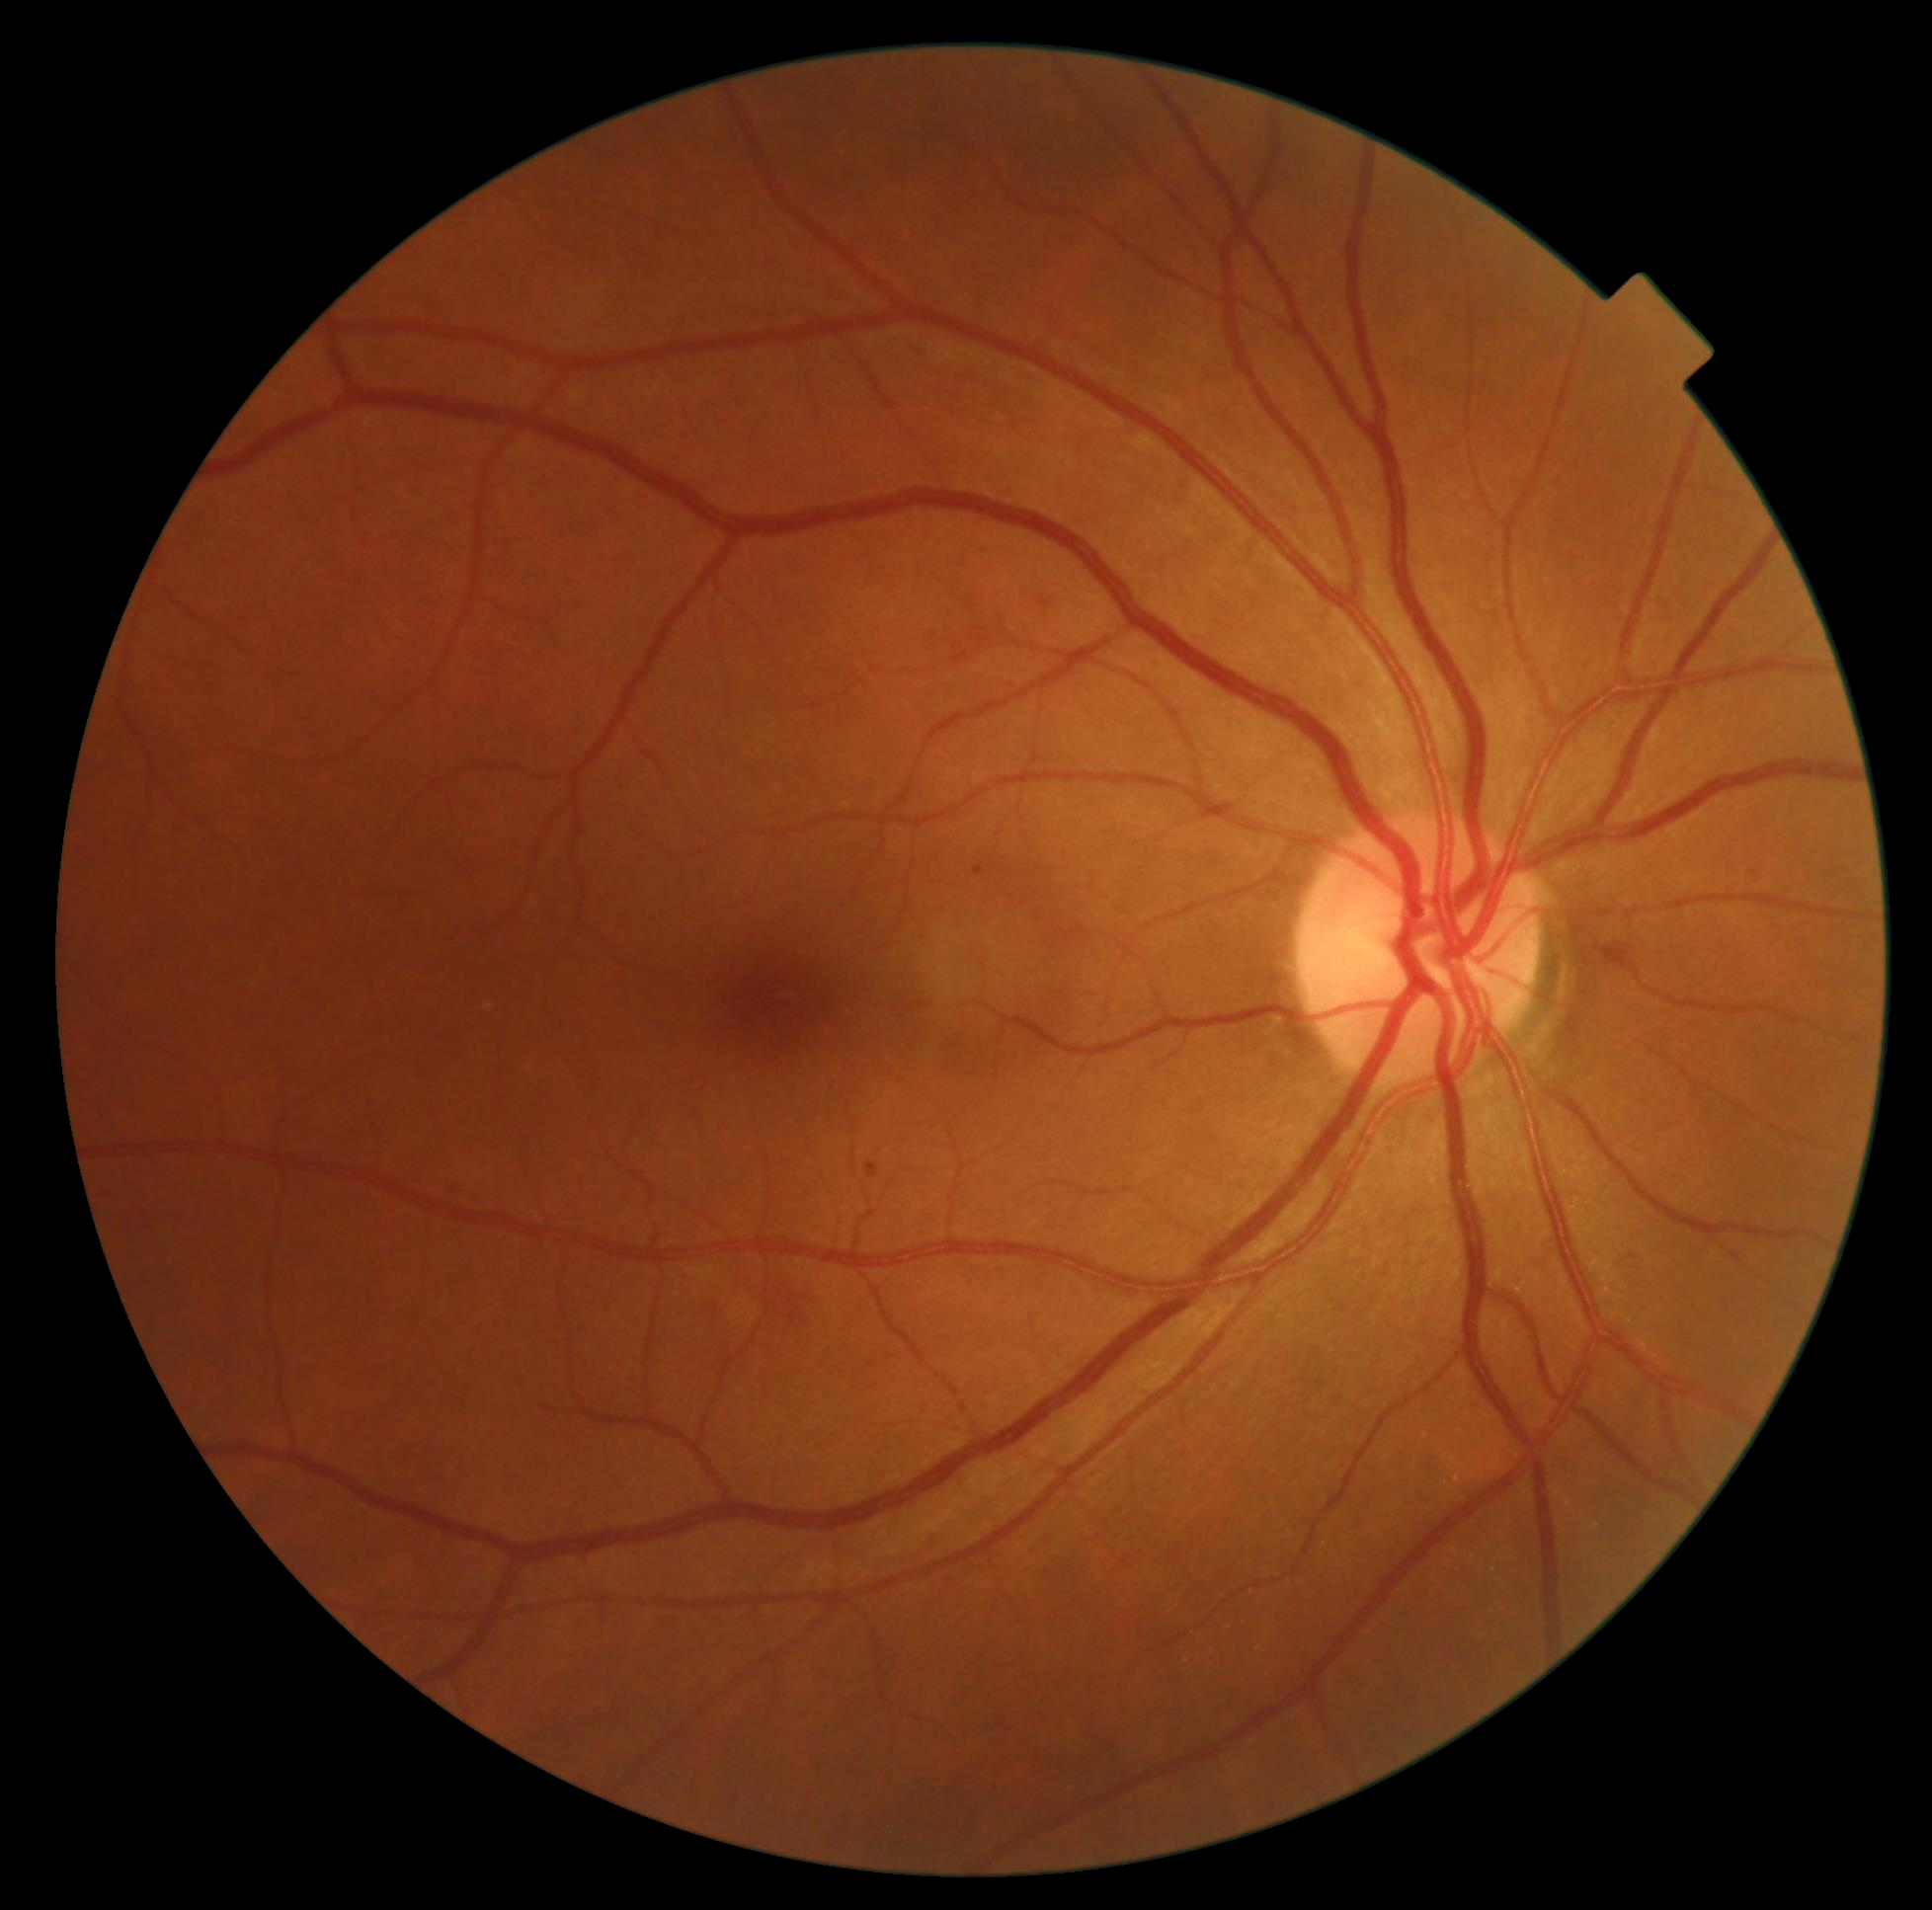

Diabetic retinopathy grade is 2 (moderate NPDR) — more than just microaneurysms but less than severe NPDR.